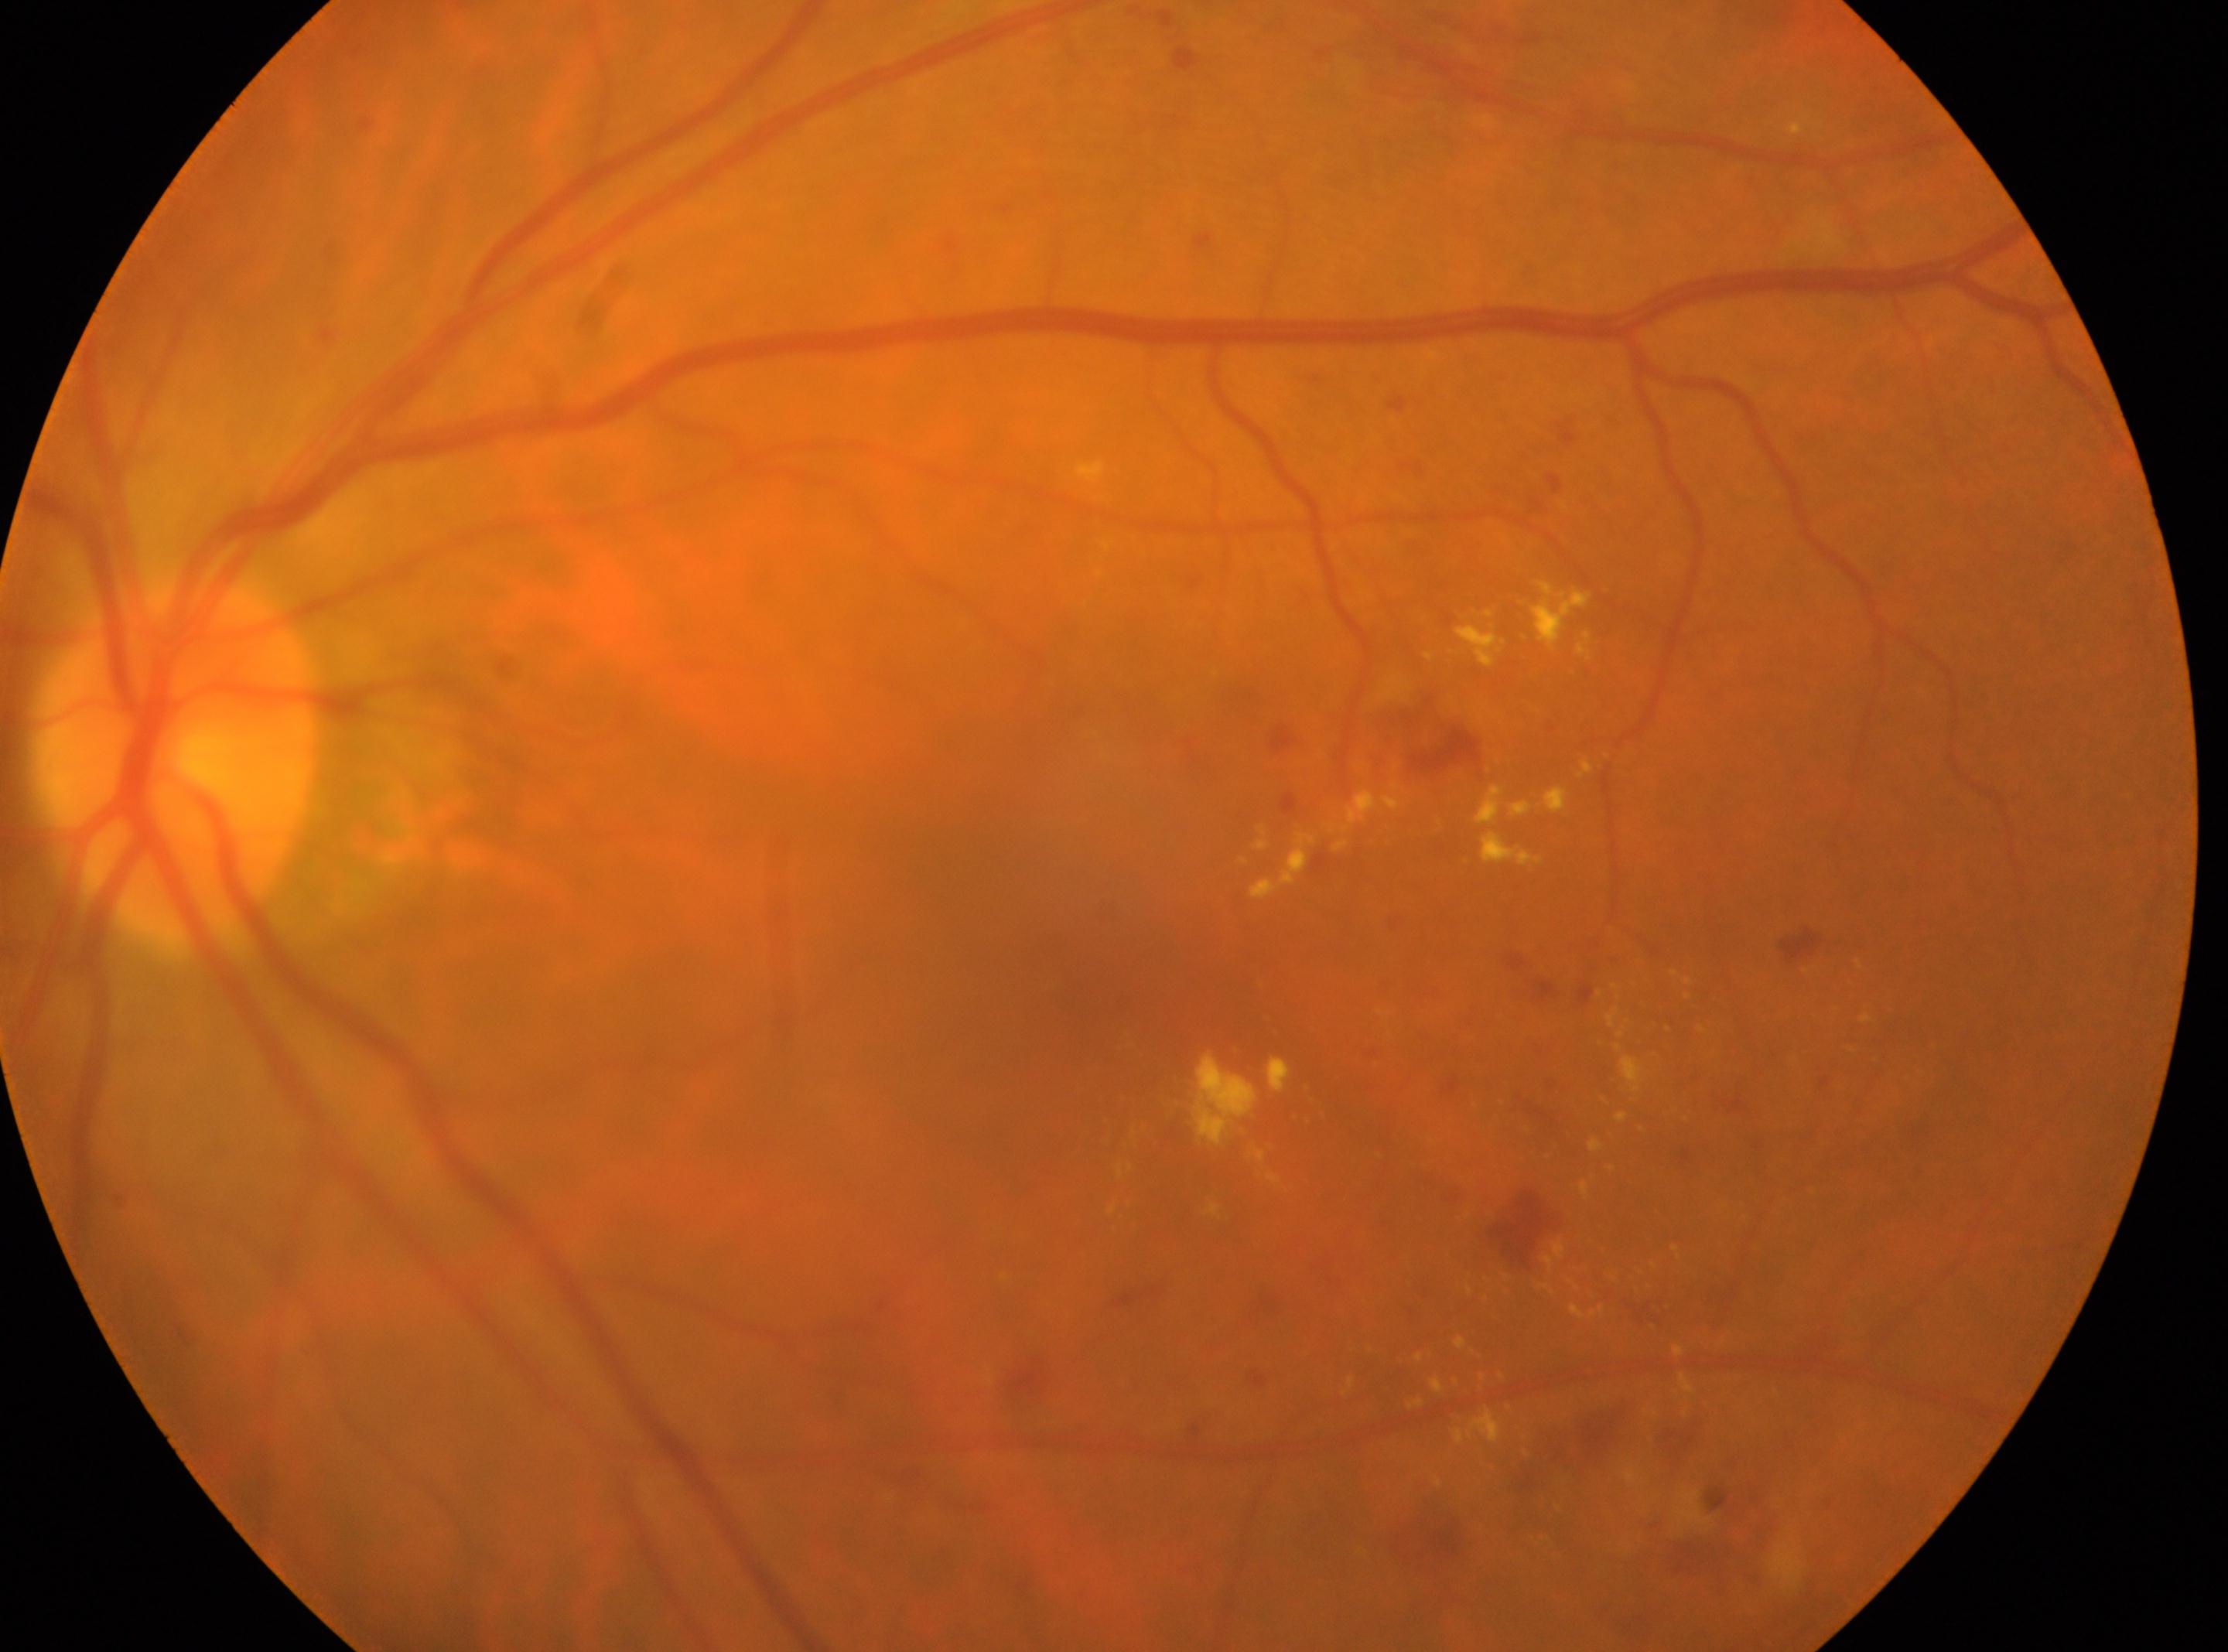 The retinopathy is classified as non-proliferative diabetic retinopathy. The foveal center is at 1094px, 954px. Diabetic retinopathy (DR): moderate non-proliferative diabetic retinopathy (grade 2). Optic nerve head located at 172px, 766px. The image shows the left eye.